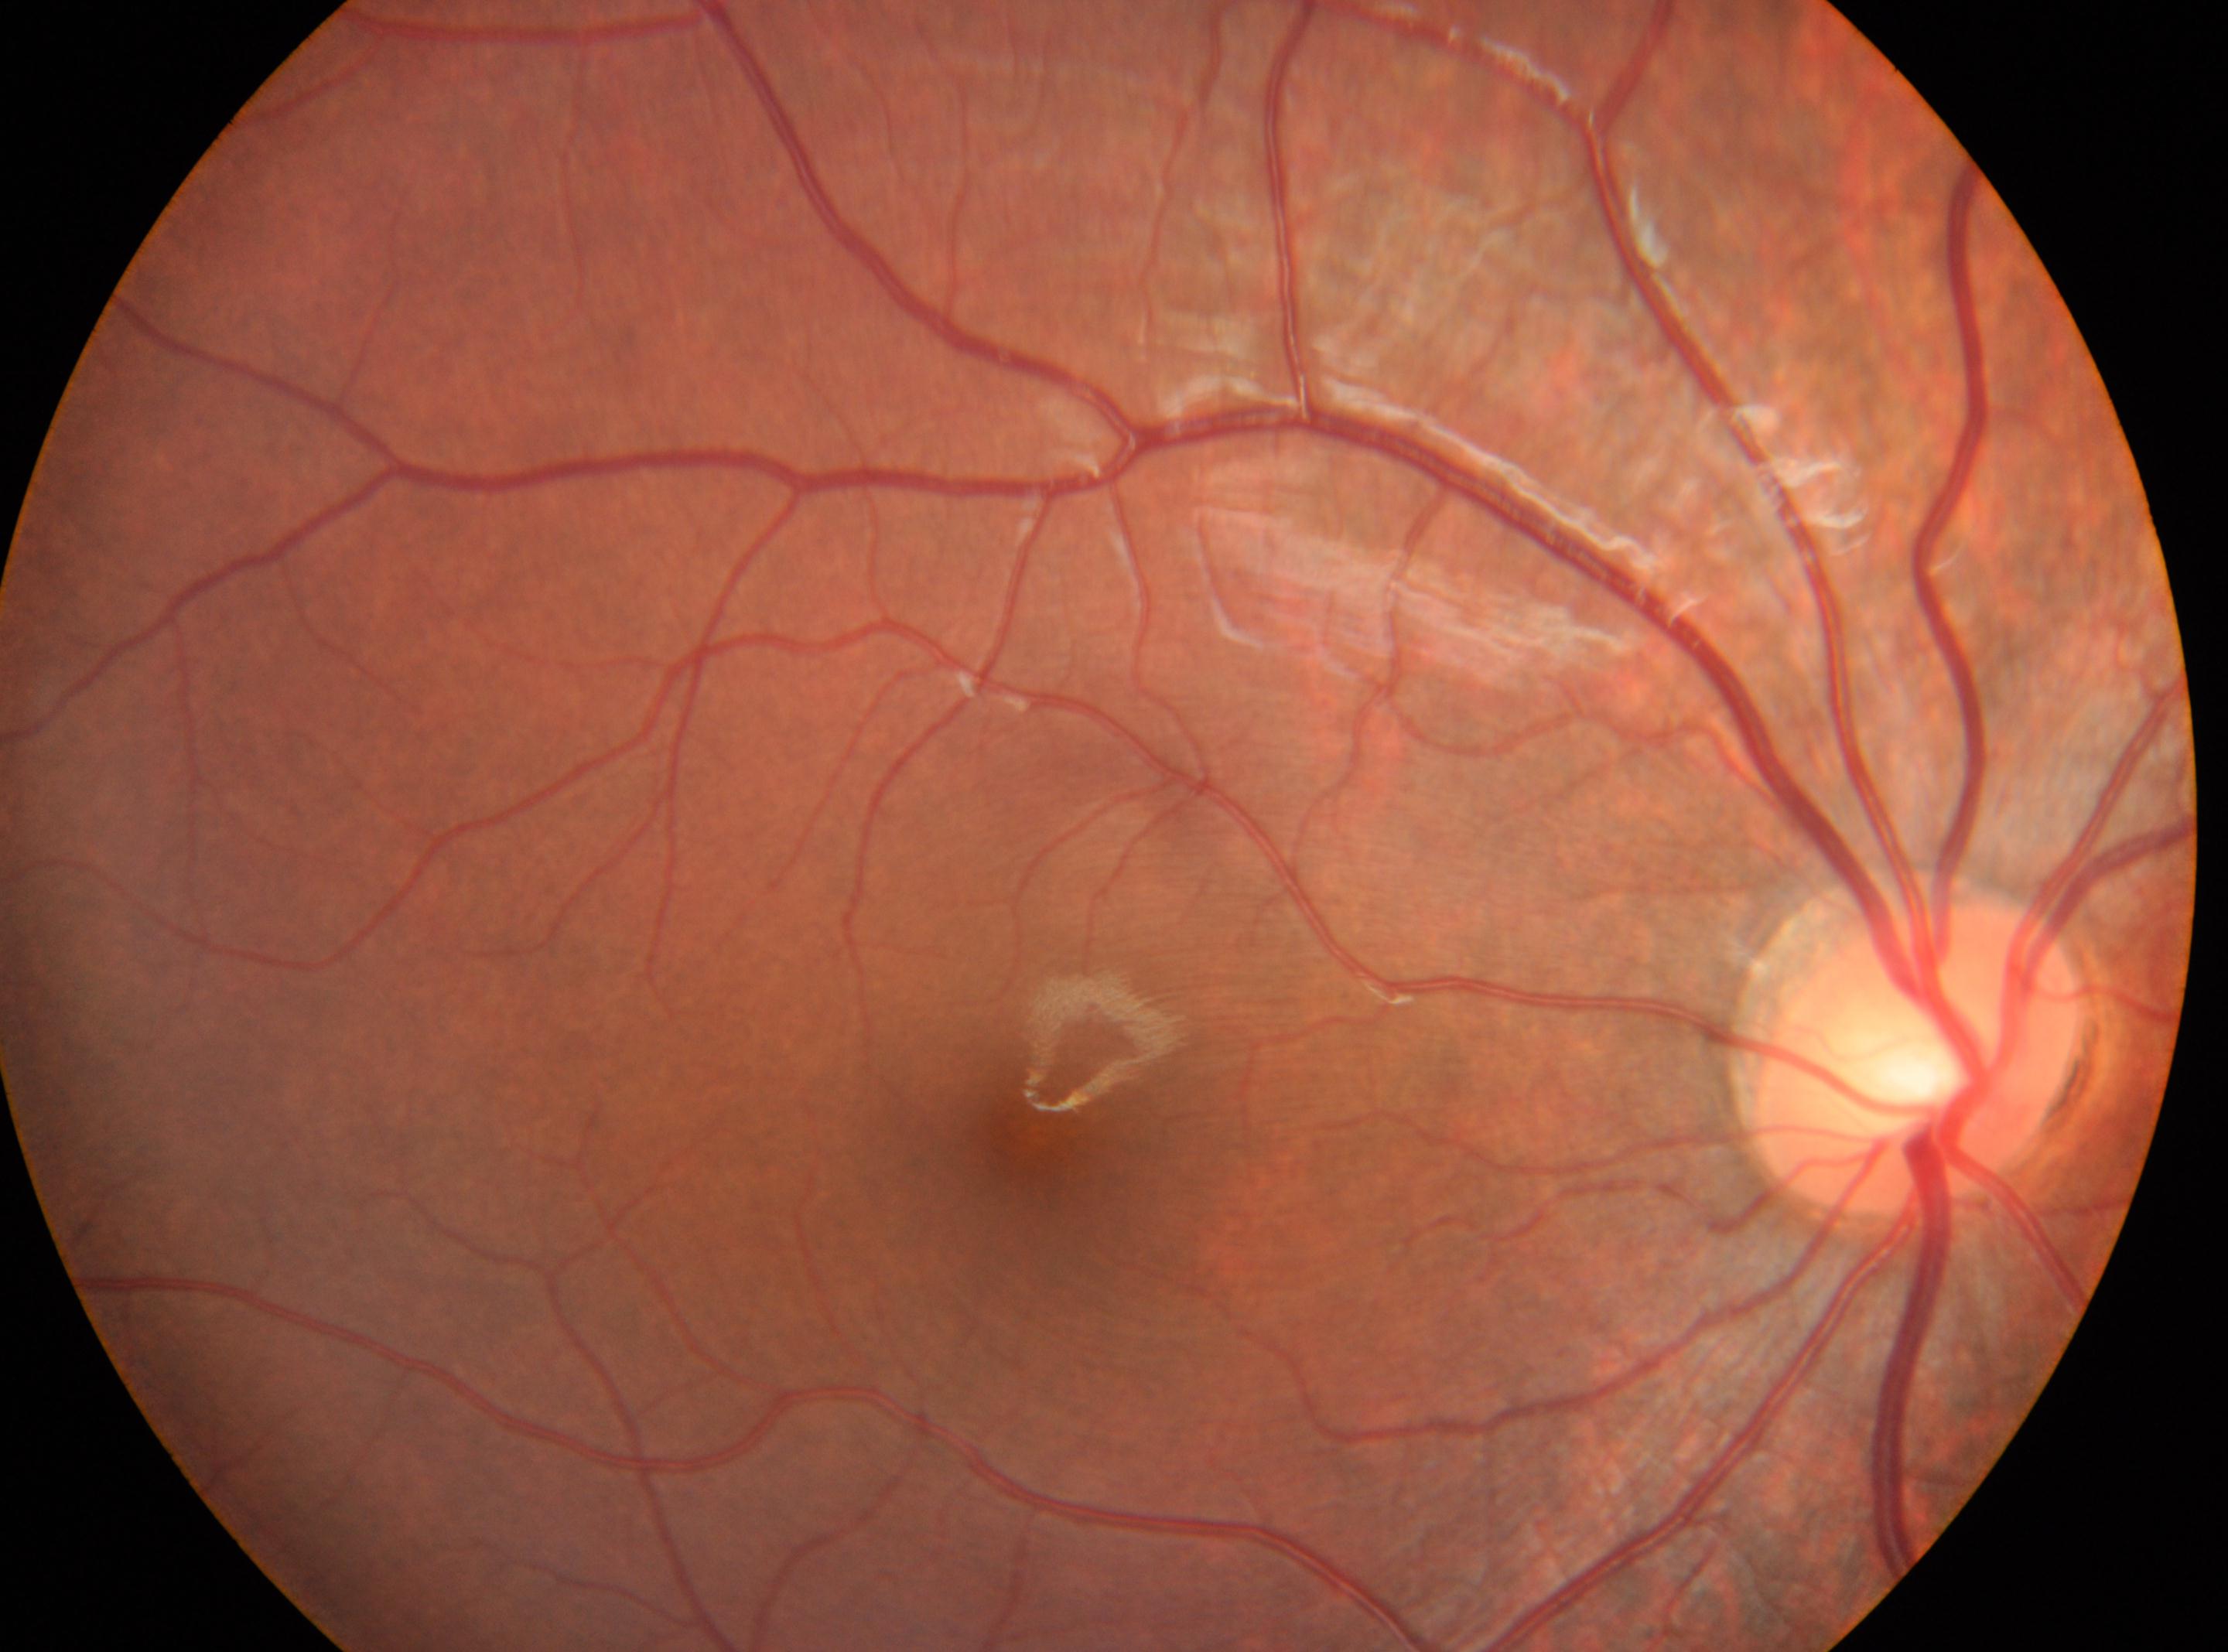

Findings:
- laterality — oculus dexter
- optic disc — (x: 1915, y: 1055)
- DR impression — No diabetic retinal disease findings
- DR severity — grade 0 (no apparent retinopathy)
- fovea center — (x: 1035, y: 1132)